Image size 1240x1240 · wide-field fundus image from infant ROP screening:
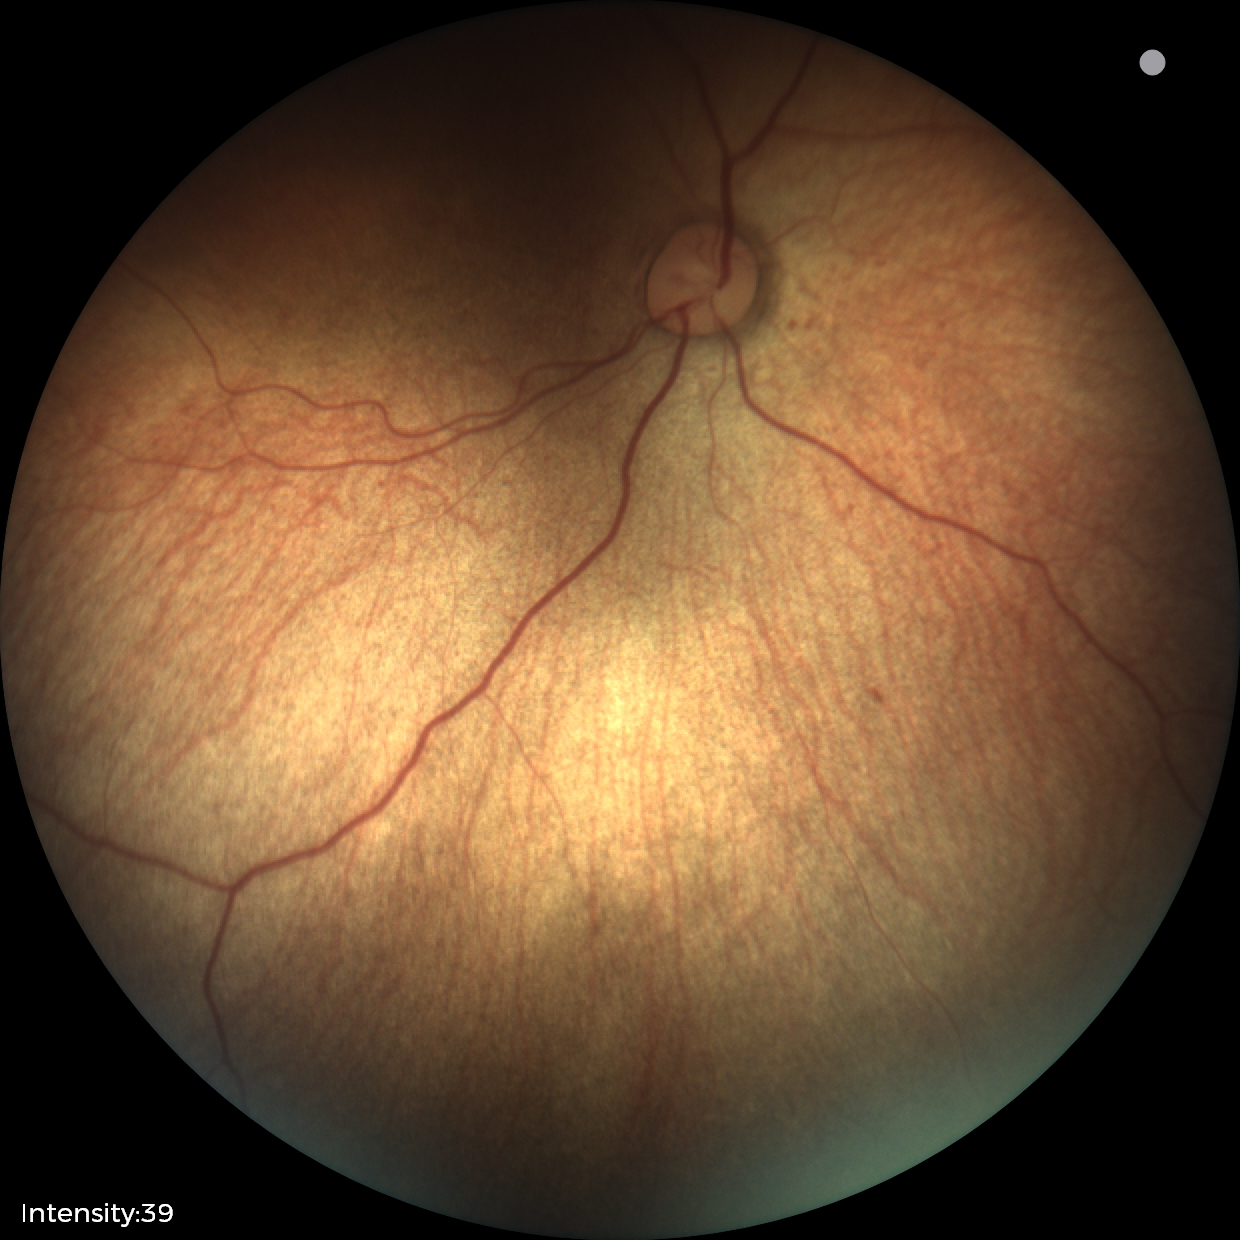
Screening examination diagnosed as physiological.